45° field of view.
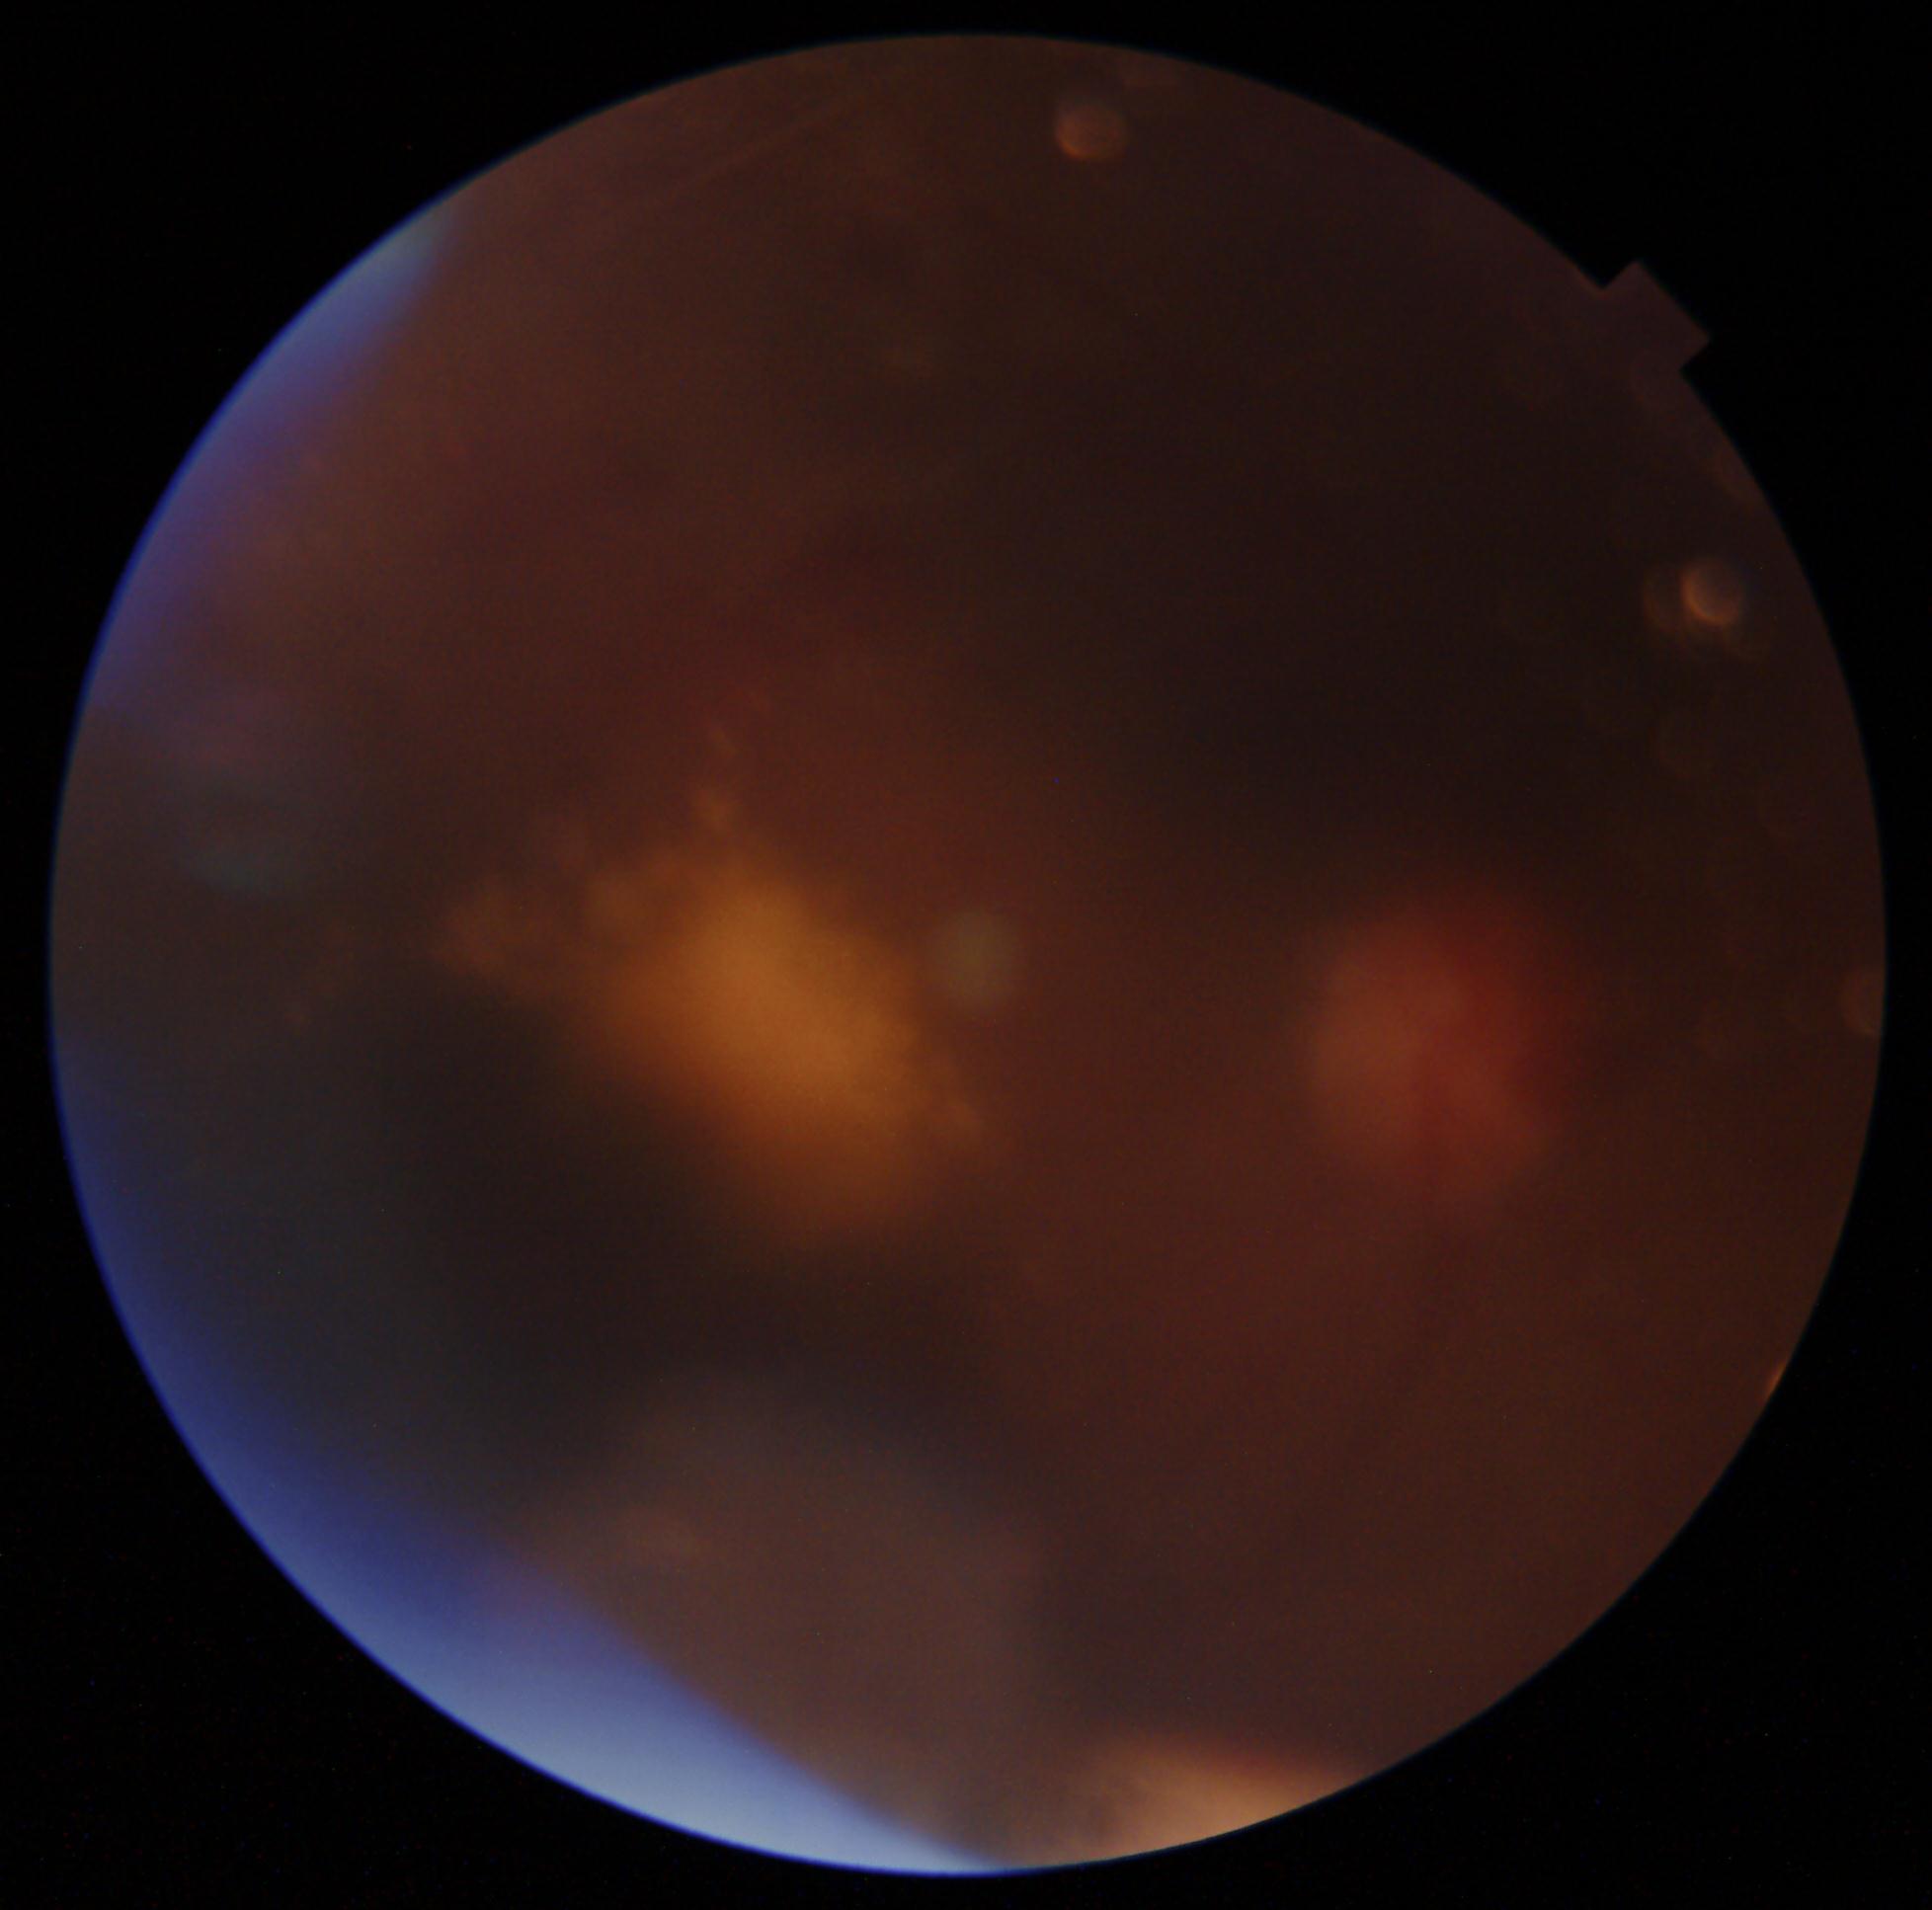
DR grade: moderate NPDR (2).